2346 x 1568 pixels
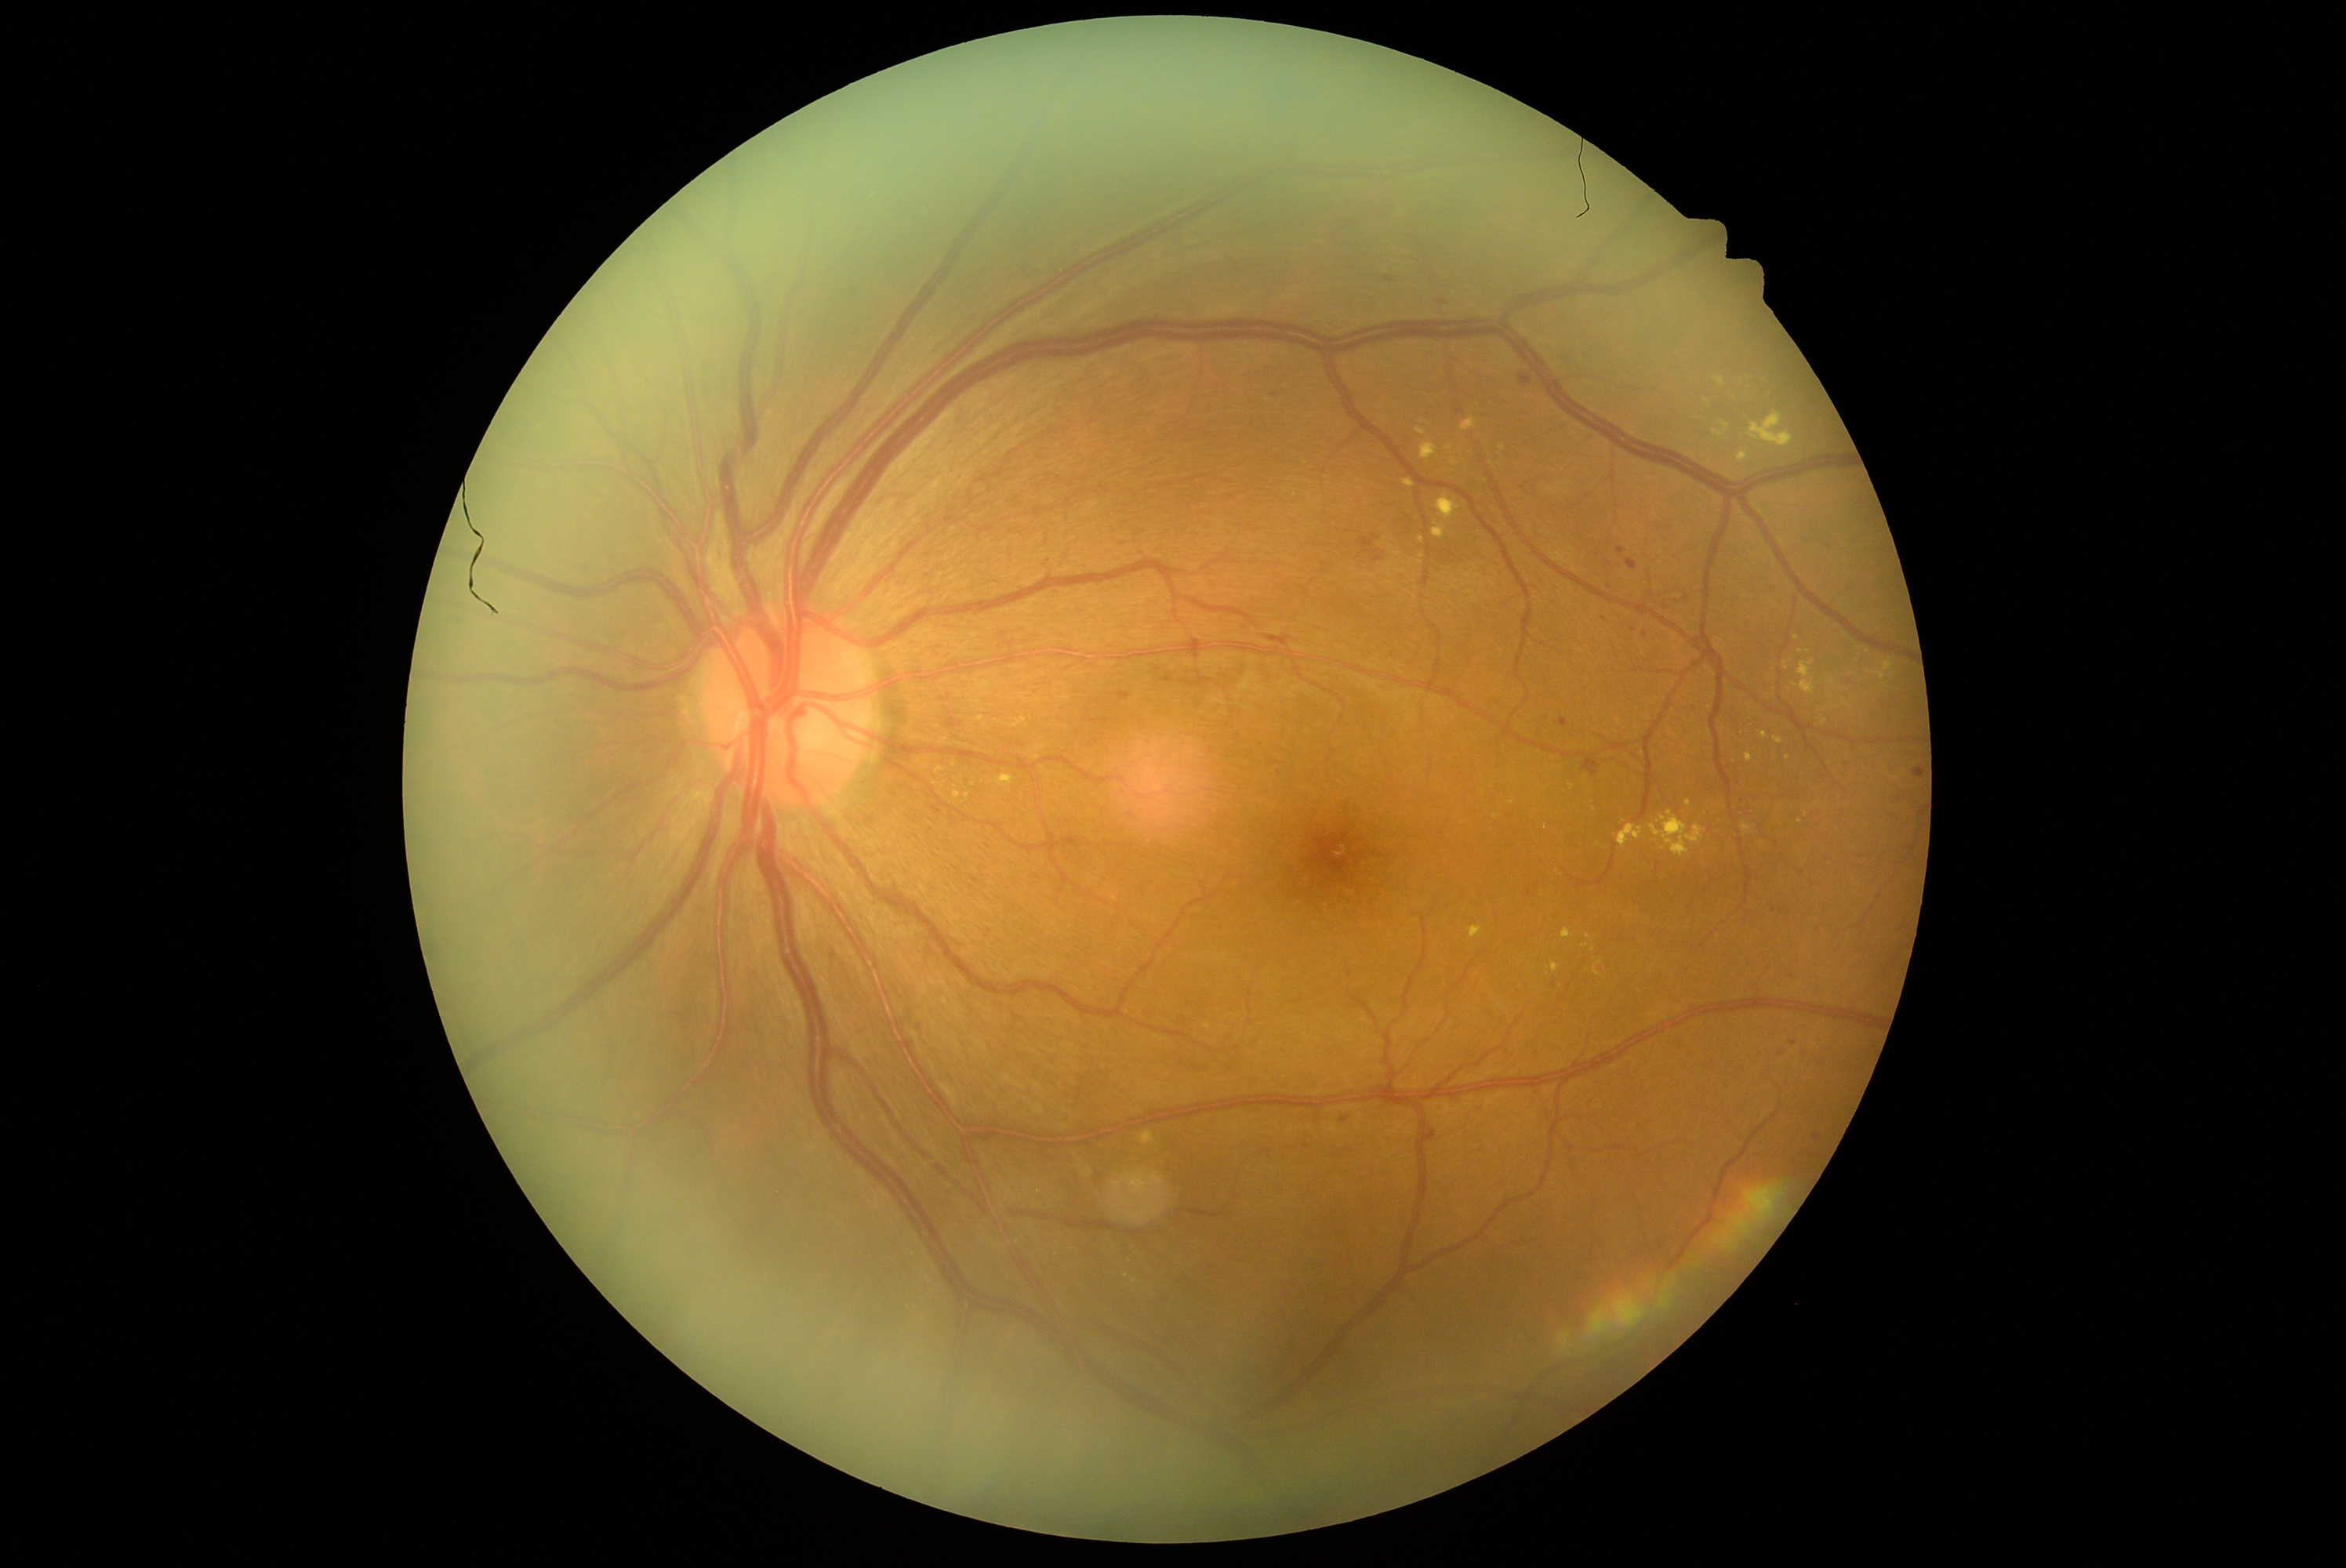
Diabetic retinopathy grade: moderate non-proliferative diabetic retinopathy (2).
Hemorrhages include those at rect(1357, 535, 1376, 554); rect(1583, 432, 1597, 443); rect(1178, 738, 1186, 747); rect(1588, 1098, 1592, 1106); rect(1737, 799, 1756, 824); rect(1914, 769, 1920, 780); rect(1760, 683, 1773, 691); rect(1657, 863, 1660, 871); rect(1155, 672, 1174, 684); rect(1815, 1061, 1826, 1070).
Small hemorrhages approximately at [1688, 597]; [1645, 636]; [1621, 551]; [1781, 1055]; [1275, 762]; [1528, 893]; [1605, 618].
No soft exudates identified.
Hard exudates include those at rect(1418, 537, 1425, 545); rect(1403, 479, 1415, 487); rect(1884, 659, 1894, 672); rect(1422, 445, 1437, 460); rect(1594, 962, 1602, 978); rect(1462, 418, 1476, 430); rect(987, 713, 1037, 730); rect(932, 753, 982, 807); rect(1552, 964, 1560, 973).
Small hard exudates approximately at [1801, 821]; [1801, 651]; [1797, 638]; [1572, 786]; [1788, 759]; [1492, 464]; [1422, 556].
No microaneurysms identified.